Retinal fundus photograph:
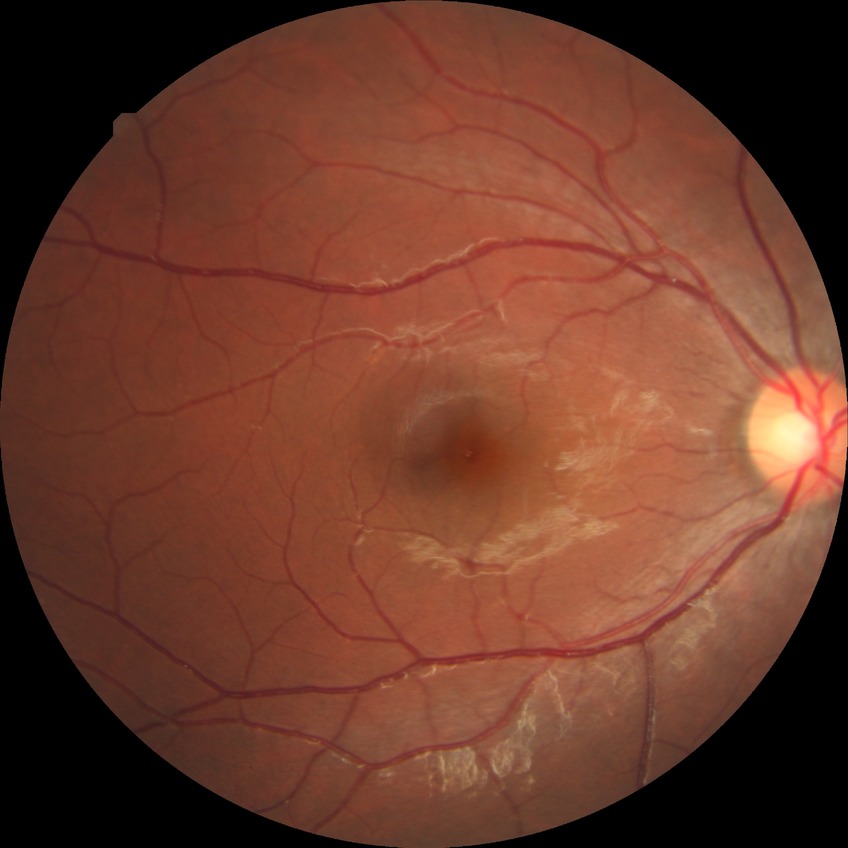 No diabetic retinal disease findings. DR grade is NDR.